Infant wide-field retinal image; 1440 x 1080 pixels
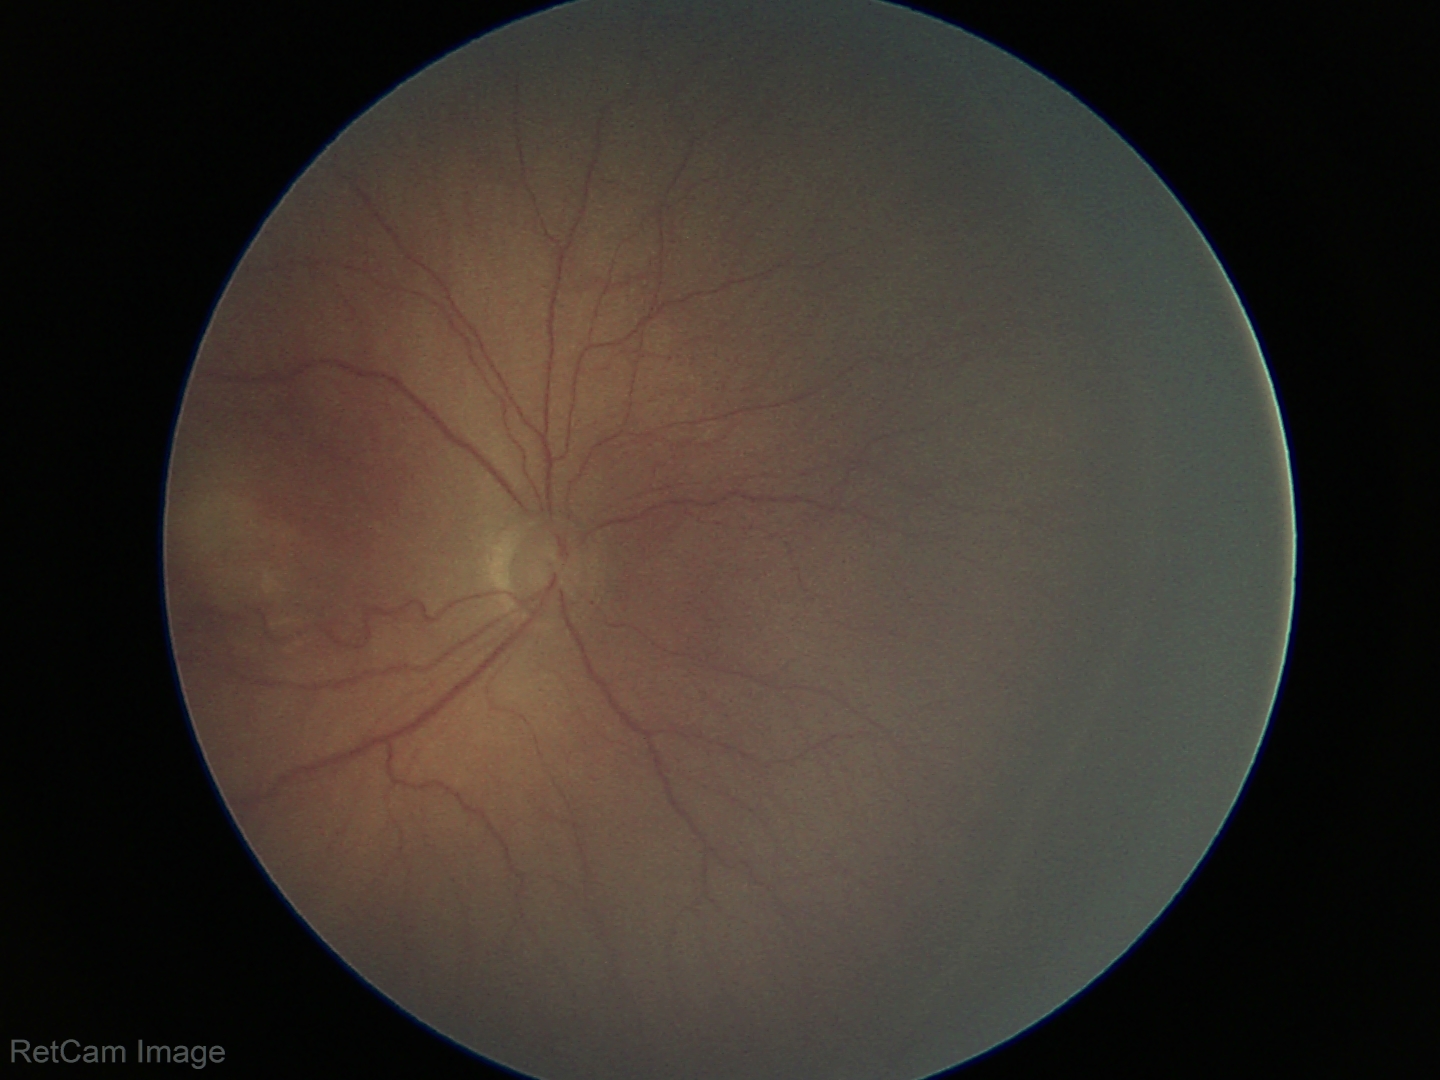

Q: What is the diagnosis from this examination?
A: ROP stage 3 — ridge with extraretinal fibrovascular proliferation
Q: Is plus disease present?
A: no plus disease — posterior pole vessels without abnormal dilation or tortuosity